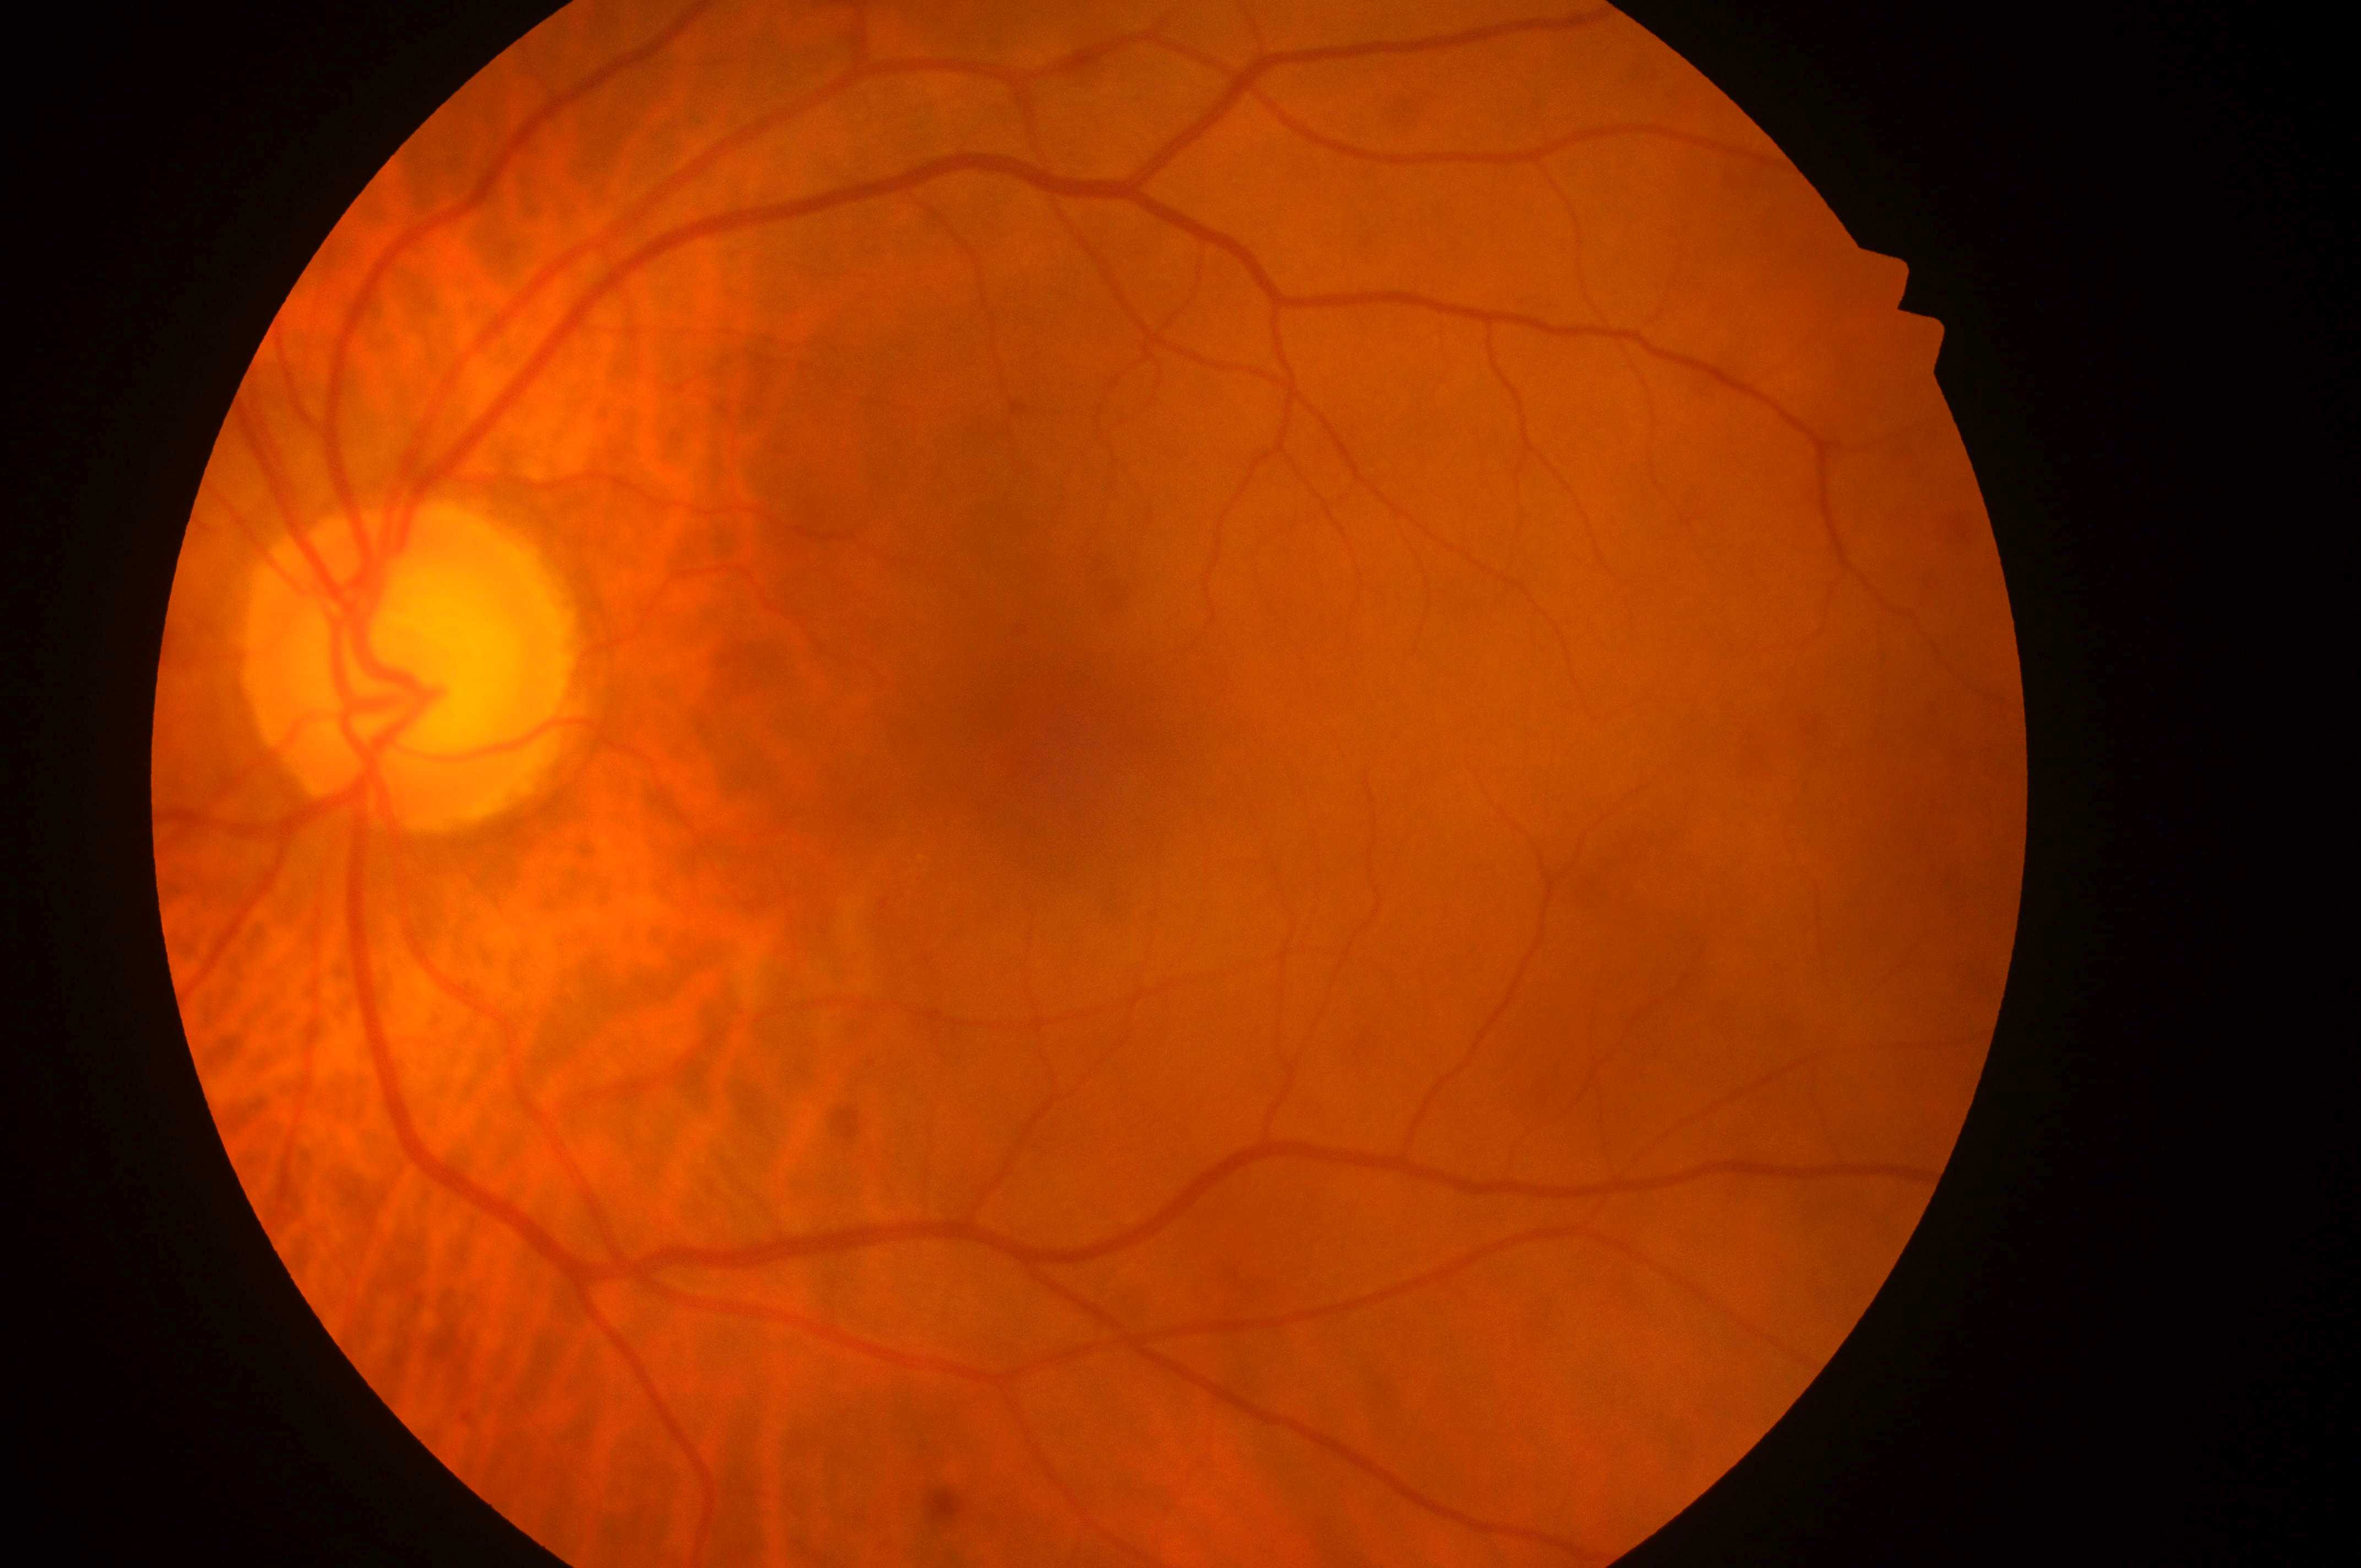

DR class = non-proliferative diabetic retinopathy | diabetic retinopathy (DR) = moderate non-proliferative diabetic retinopathy (grade 2) | diabetic macular edema (DME) = high risk (grade 2) | ONH = (402, 676) | foveal center = (1075, 750) | laterality = oculus sinister.